Color fundus photograph · 1920 x 1440 pixels: 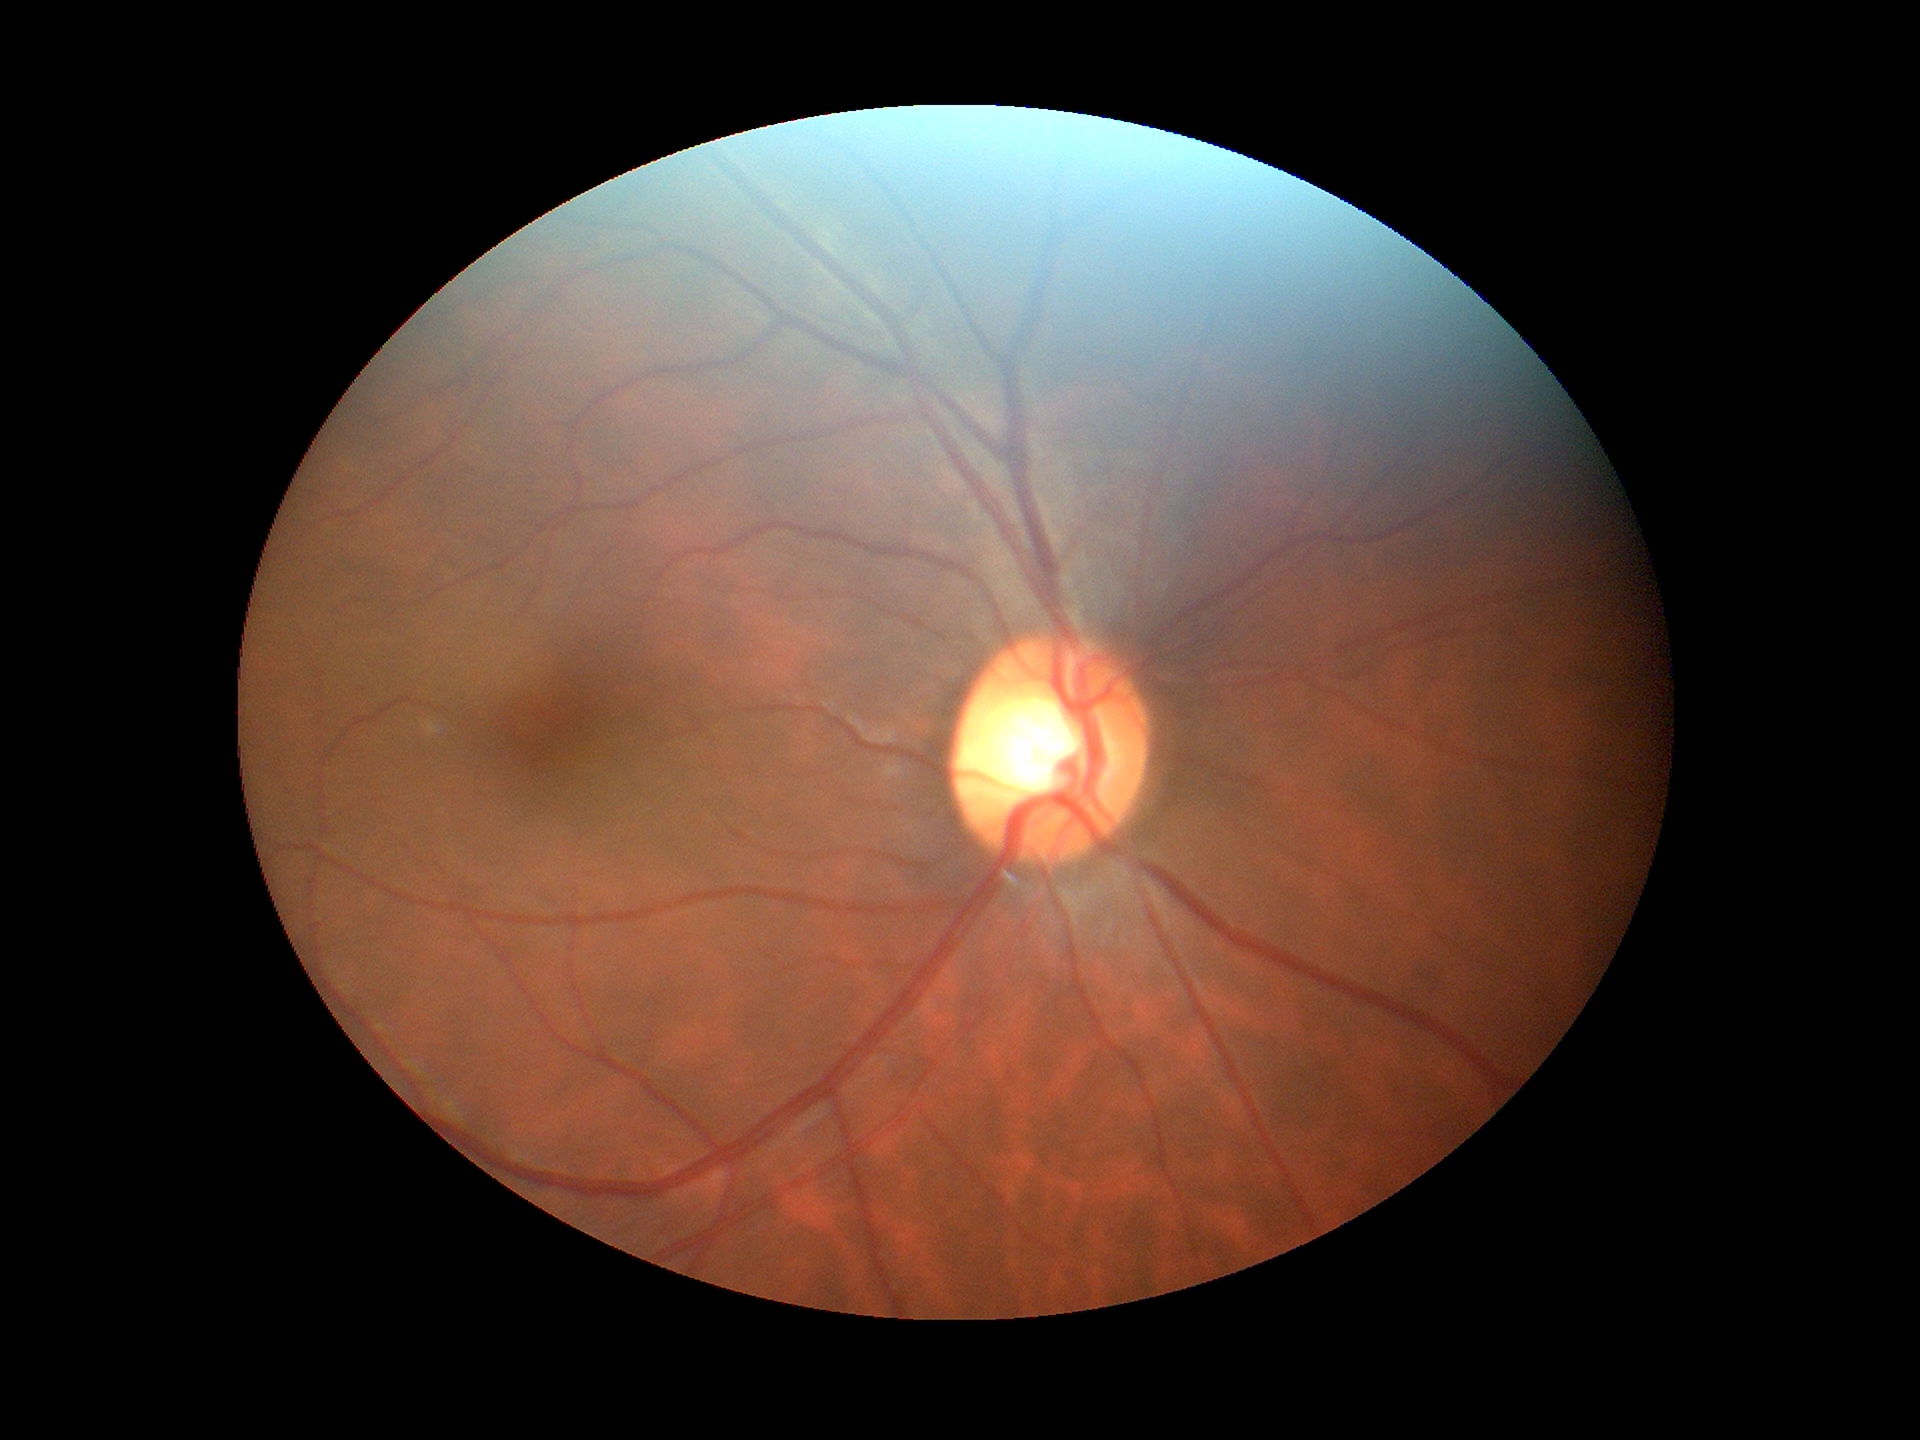 Findings:
– Glaucoma assessment: not suspect
– vertical cup-to-disc ratio: 0.55
– horizontal C/D ratio: 0.58